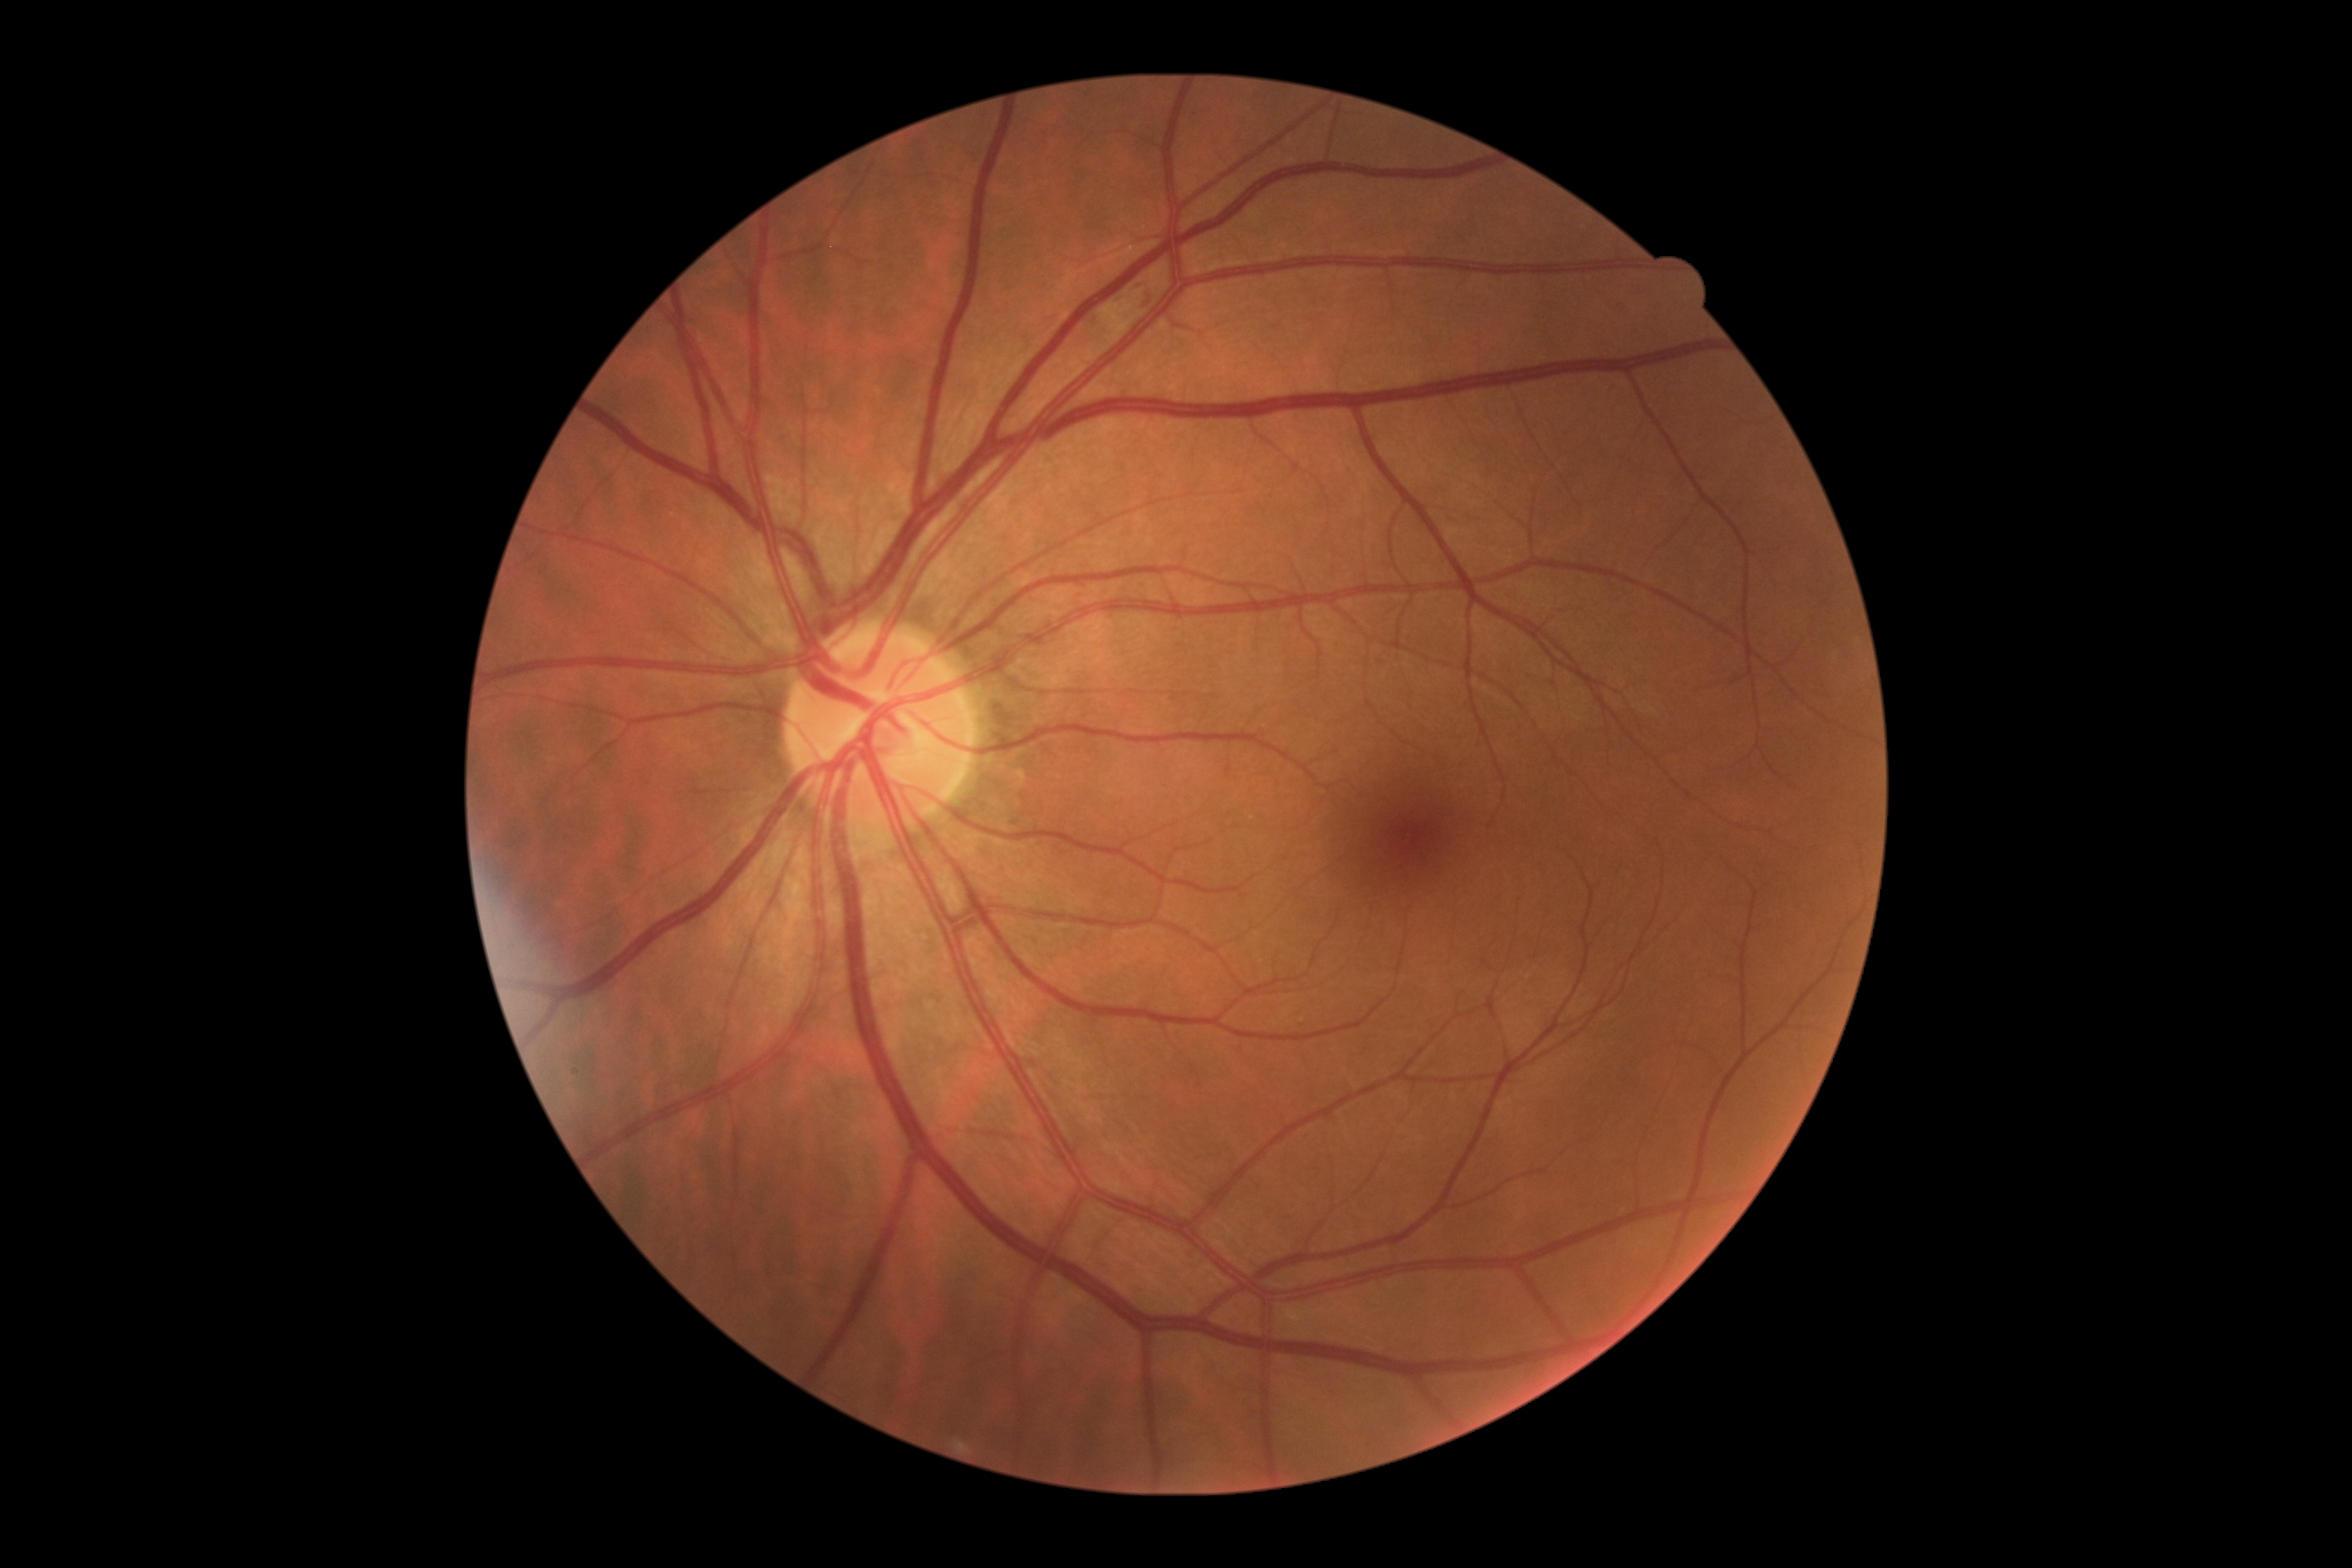 diabetic retinopathy (DR): grade 2 (moderate NPDR).